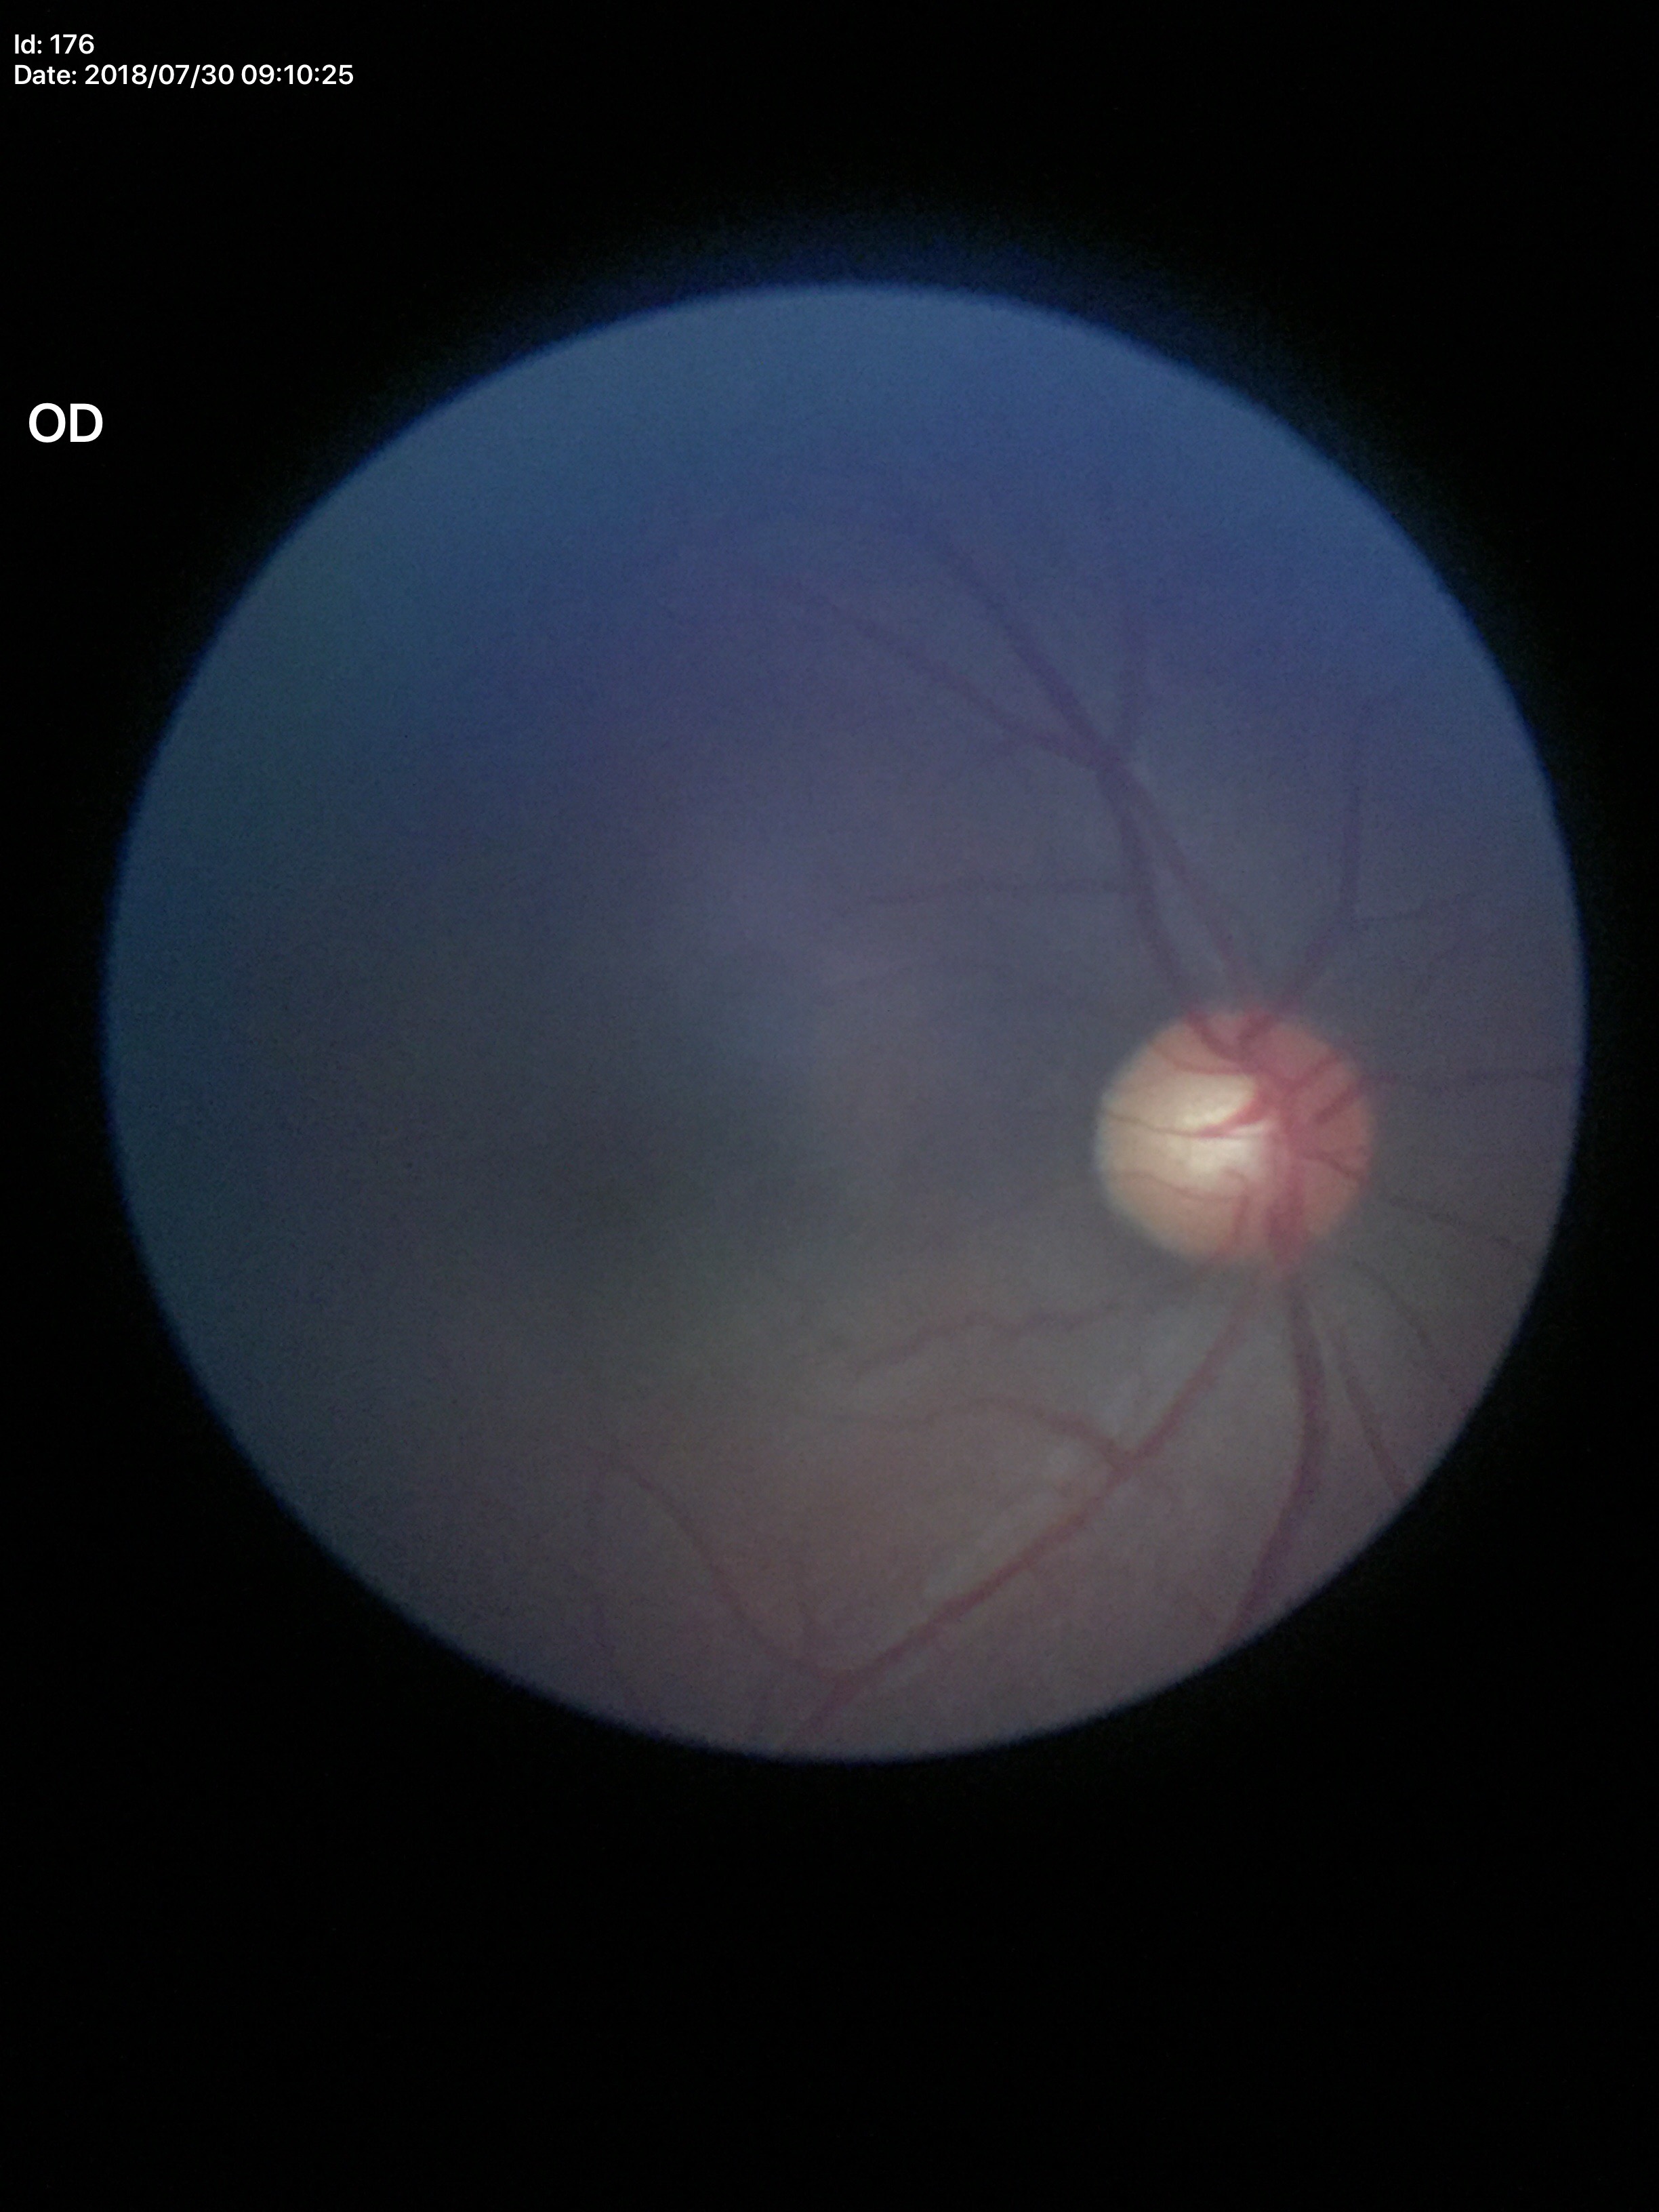

Glaucoma evaluation: no suspicious findings. VCDR is 0.56.